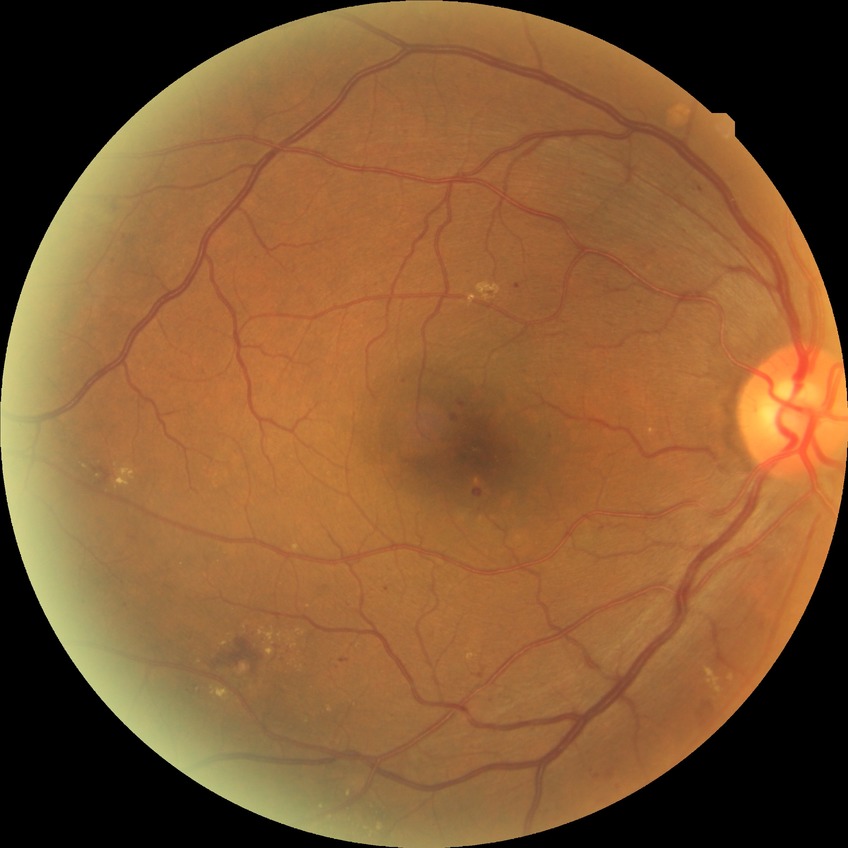

diabetic retinopathy (DR) = simple diabetic retinopathy (SDR)